Fundus photo — 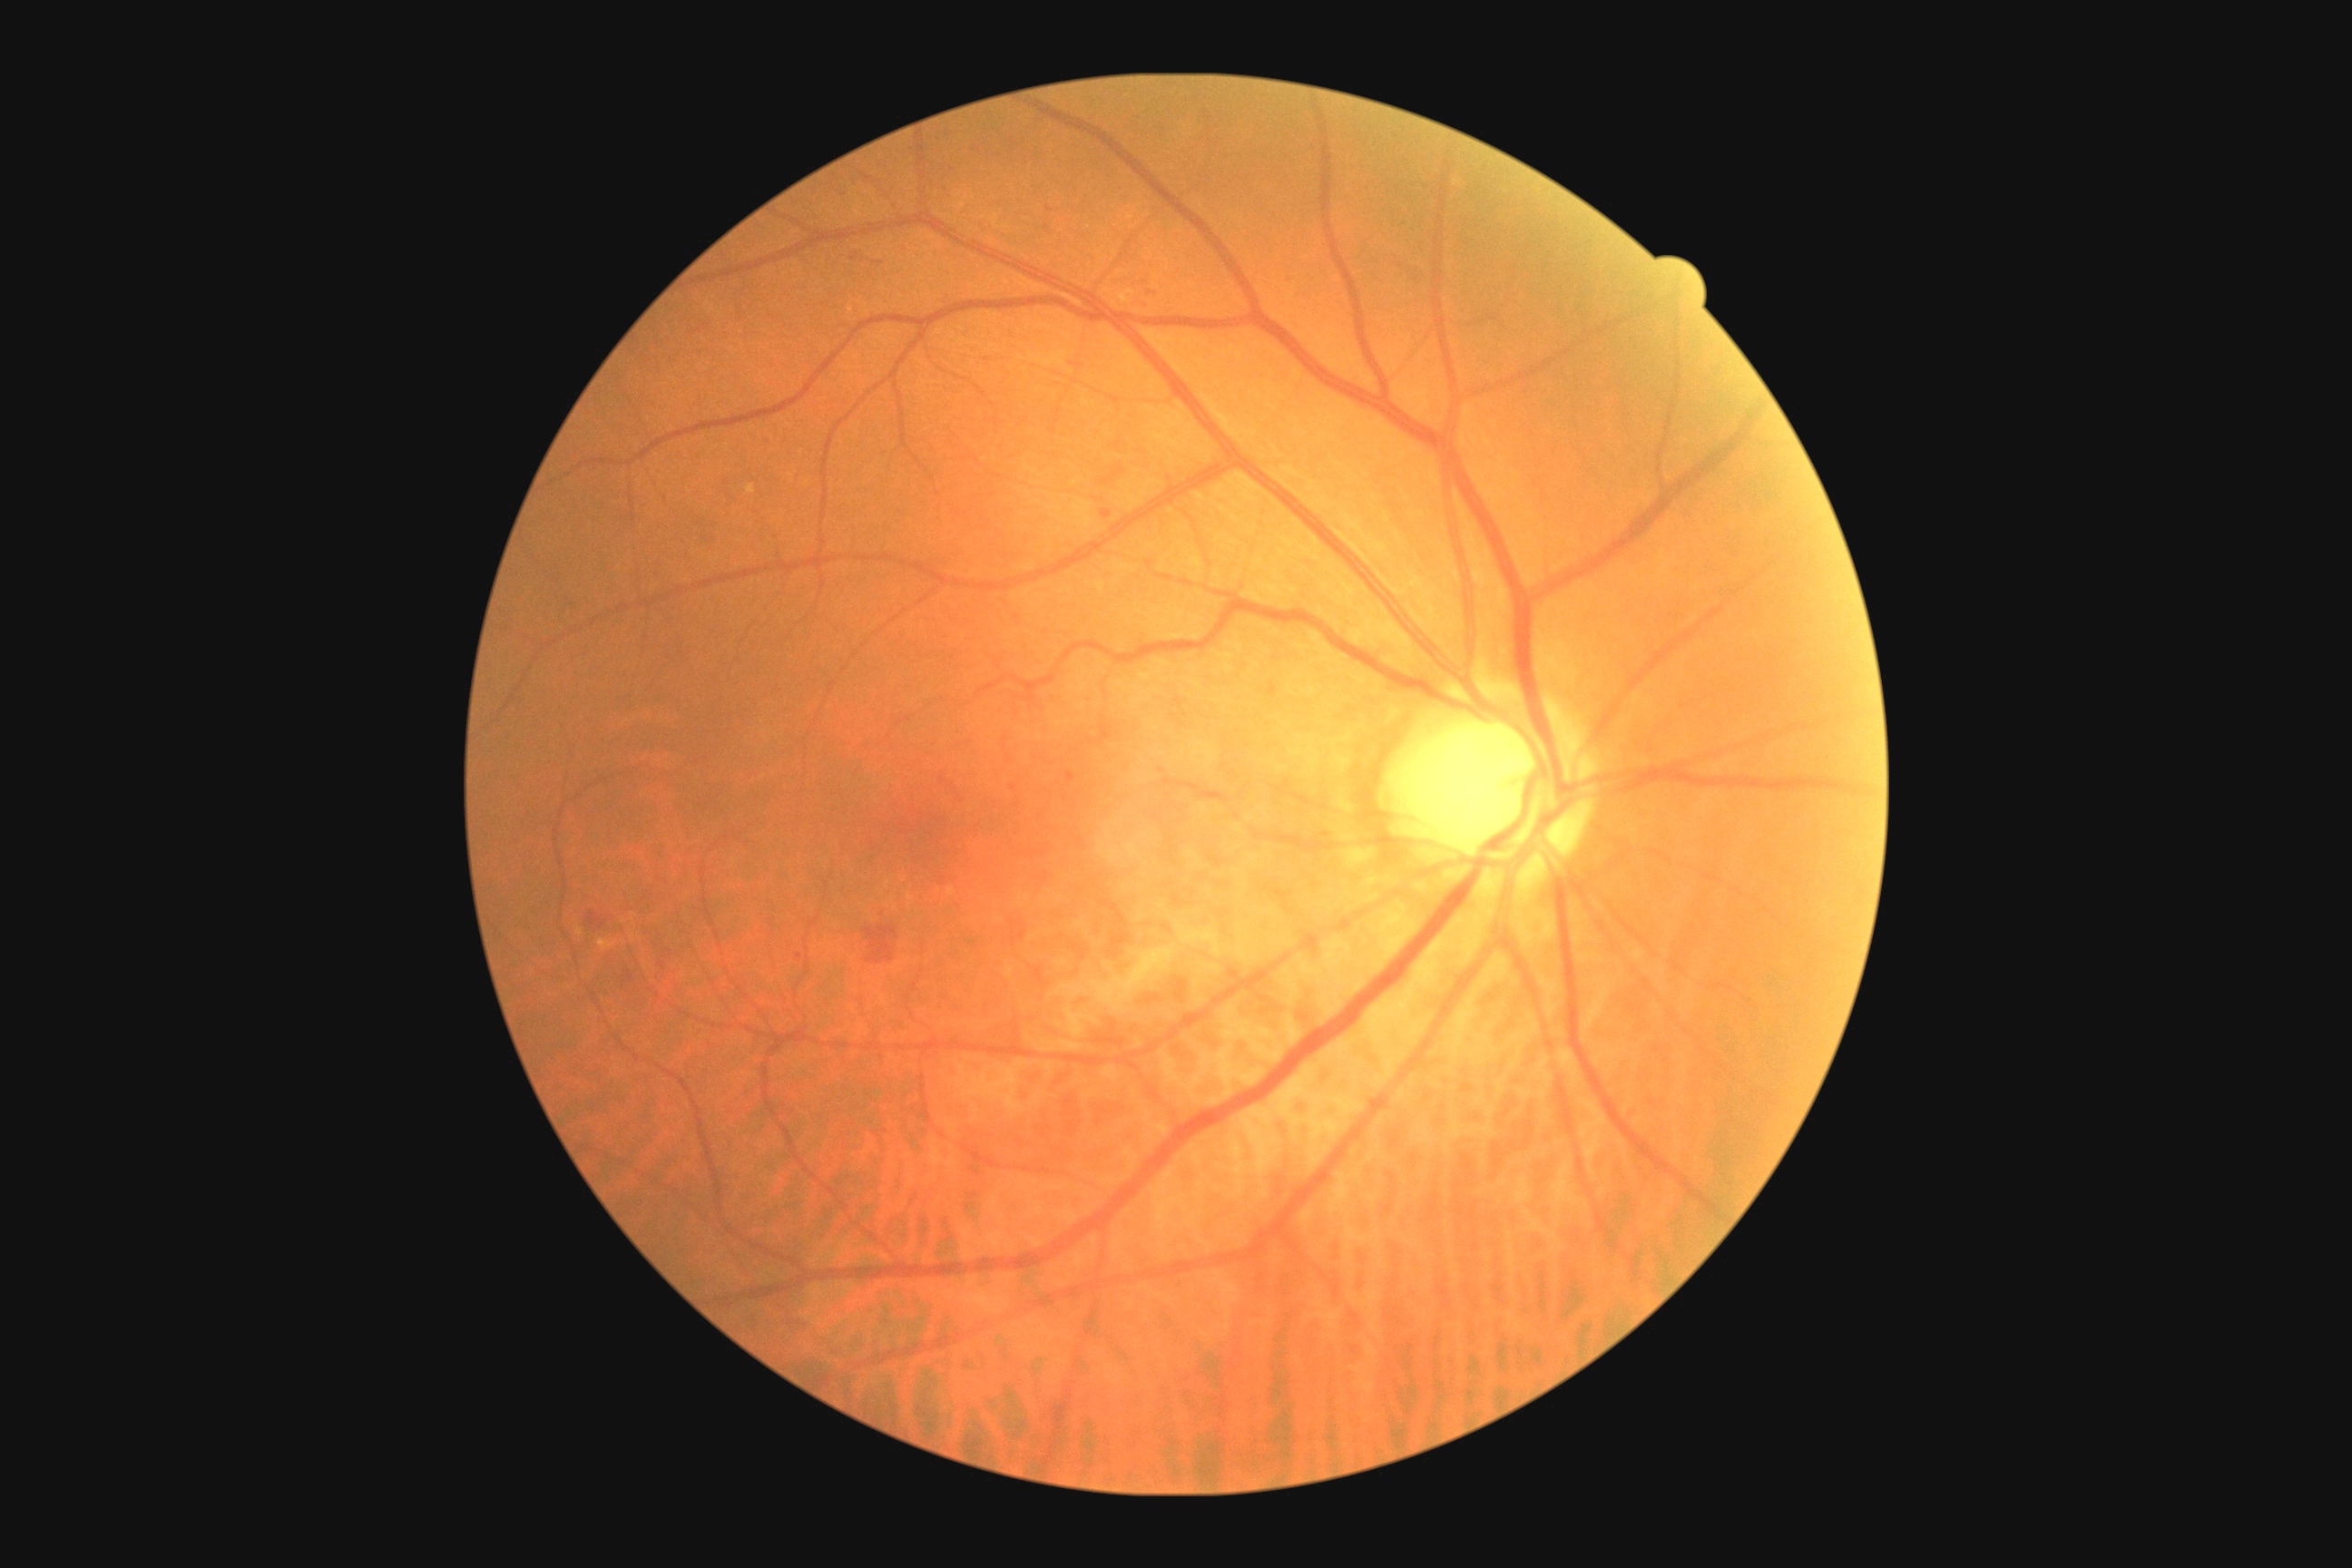
Diabetic retinopathy grade: 2 (moderate NPDR).
DR class: non-proliferative diabetic retinopathy.